RetCam wide-field infant fundus image
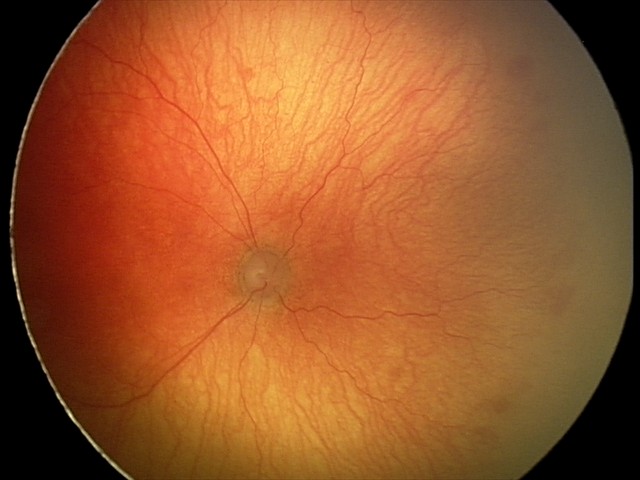 Plus disease was diagnosed. Series diagnosed as aggressive ROP (A-ROP).